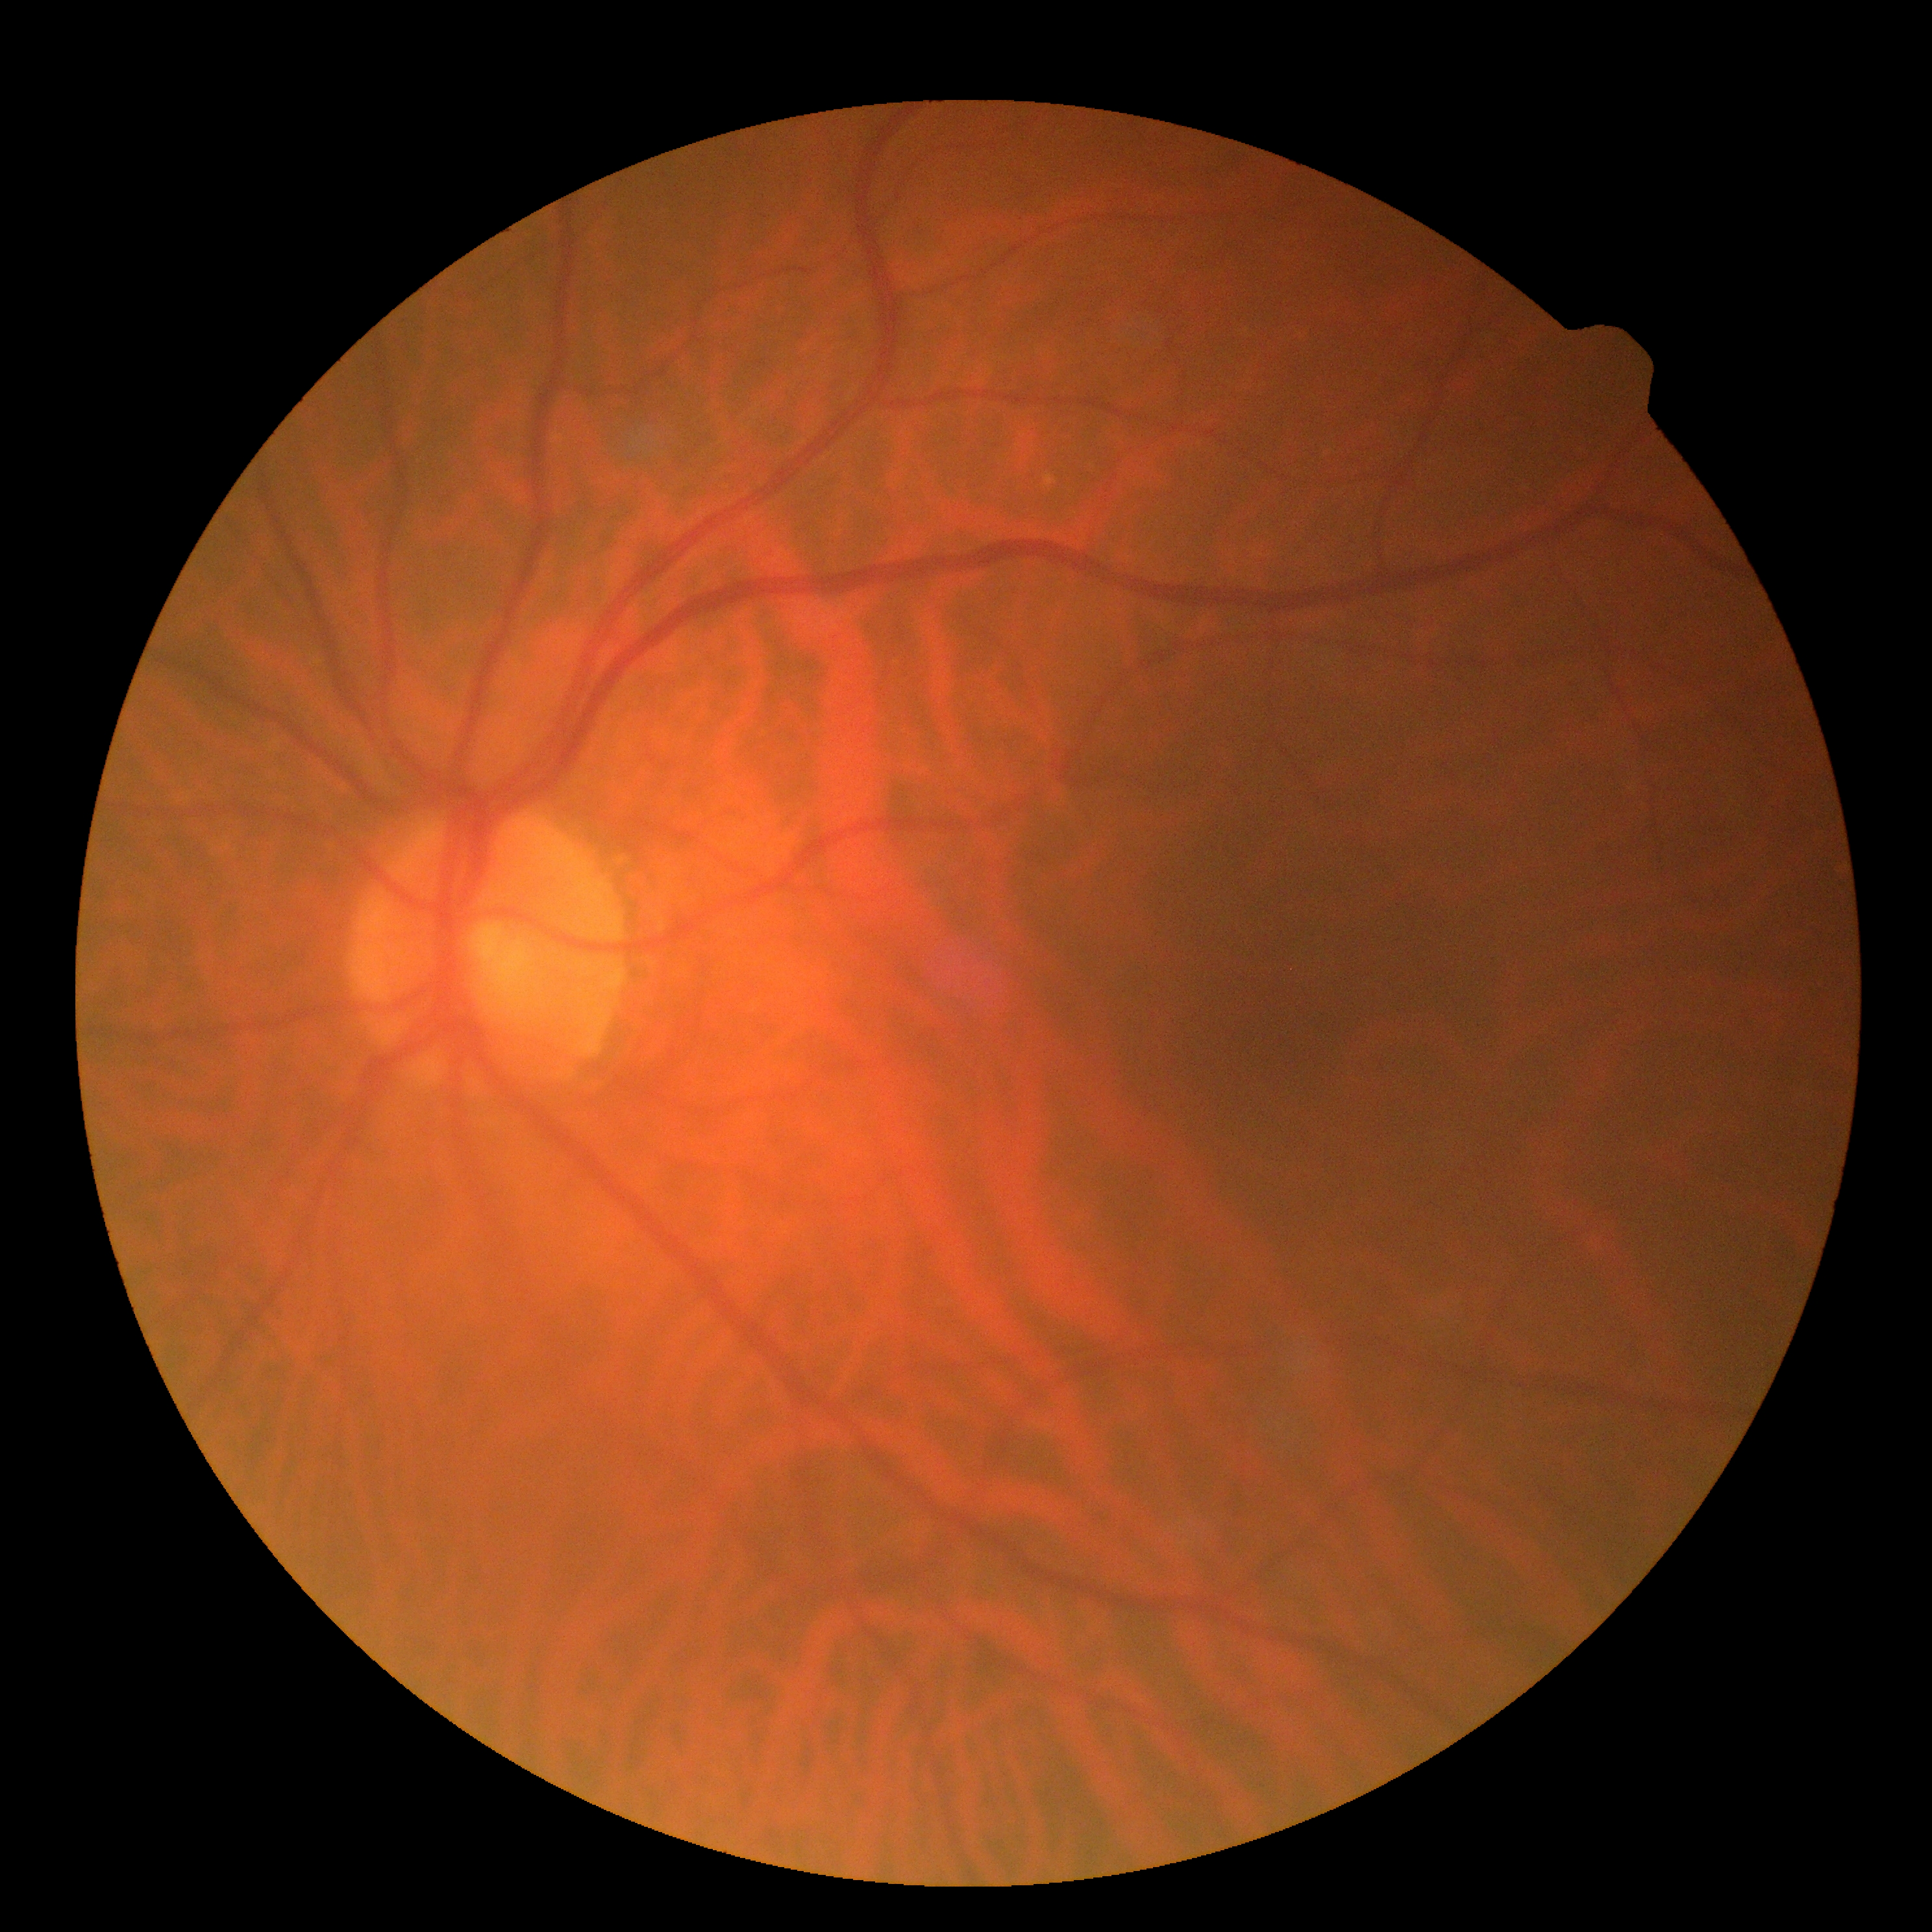

DR stage@0/4 — no visible signs of diabetic retinopathy.